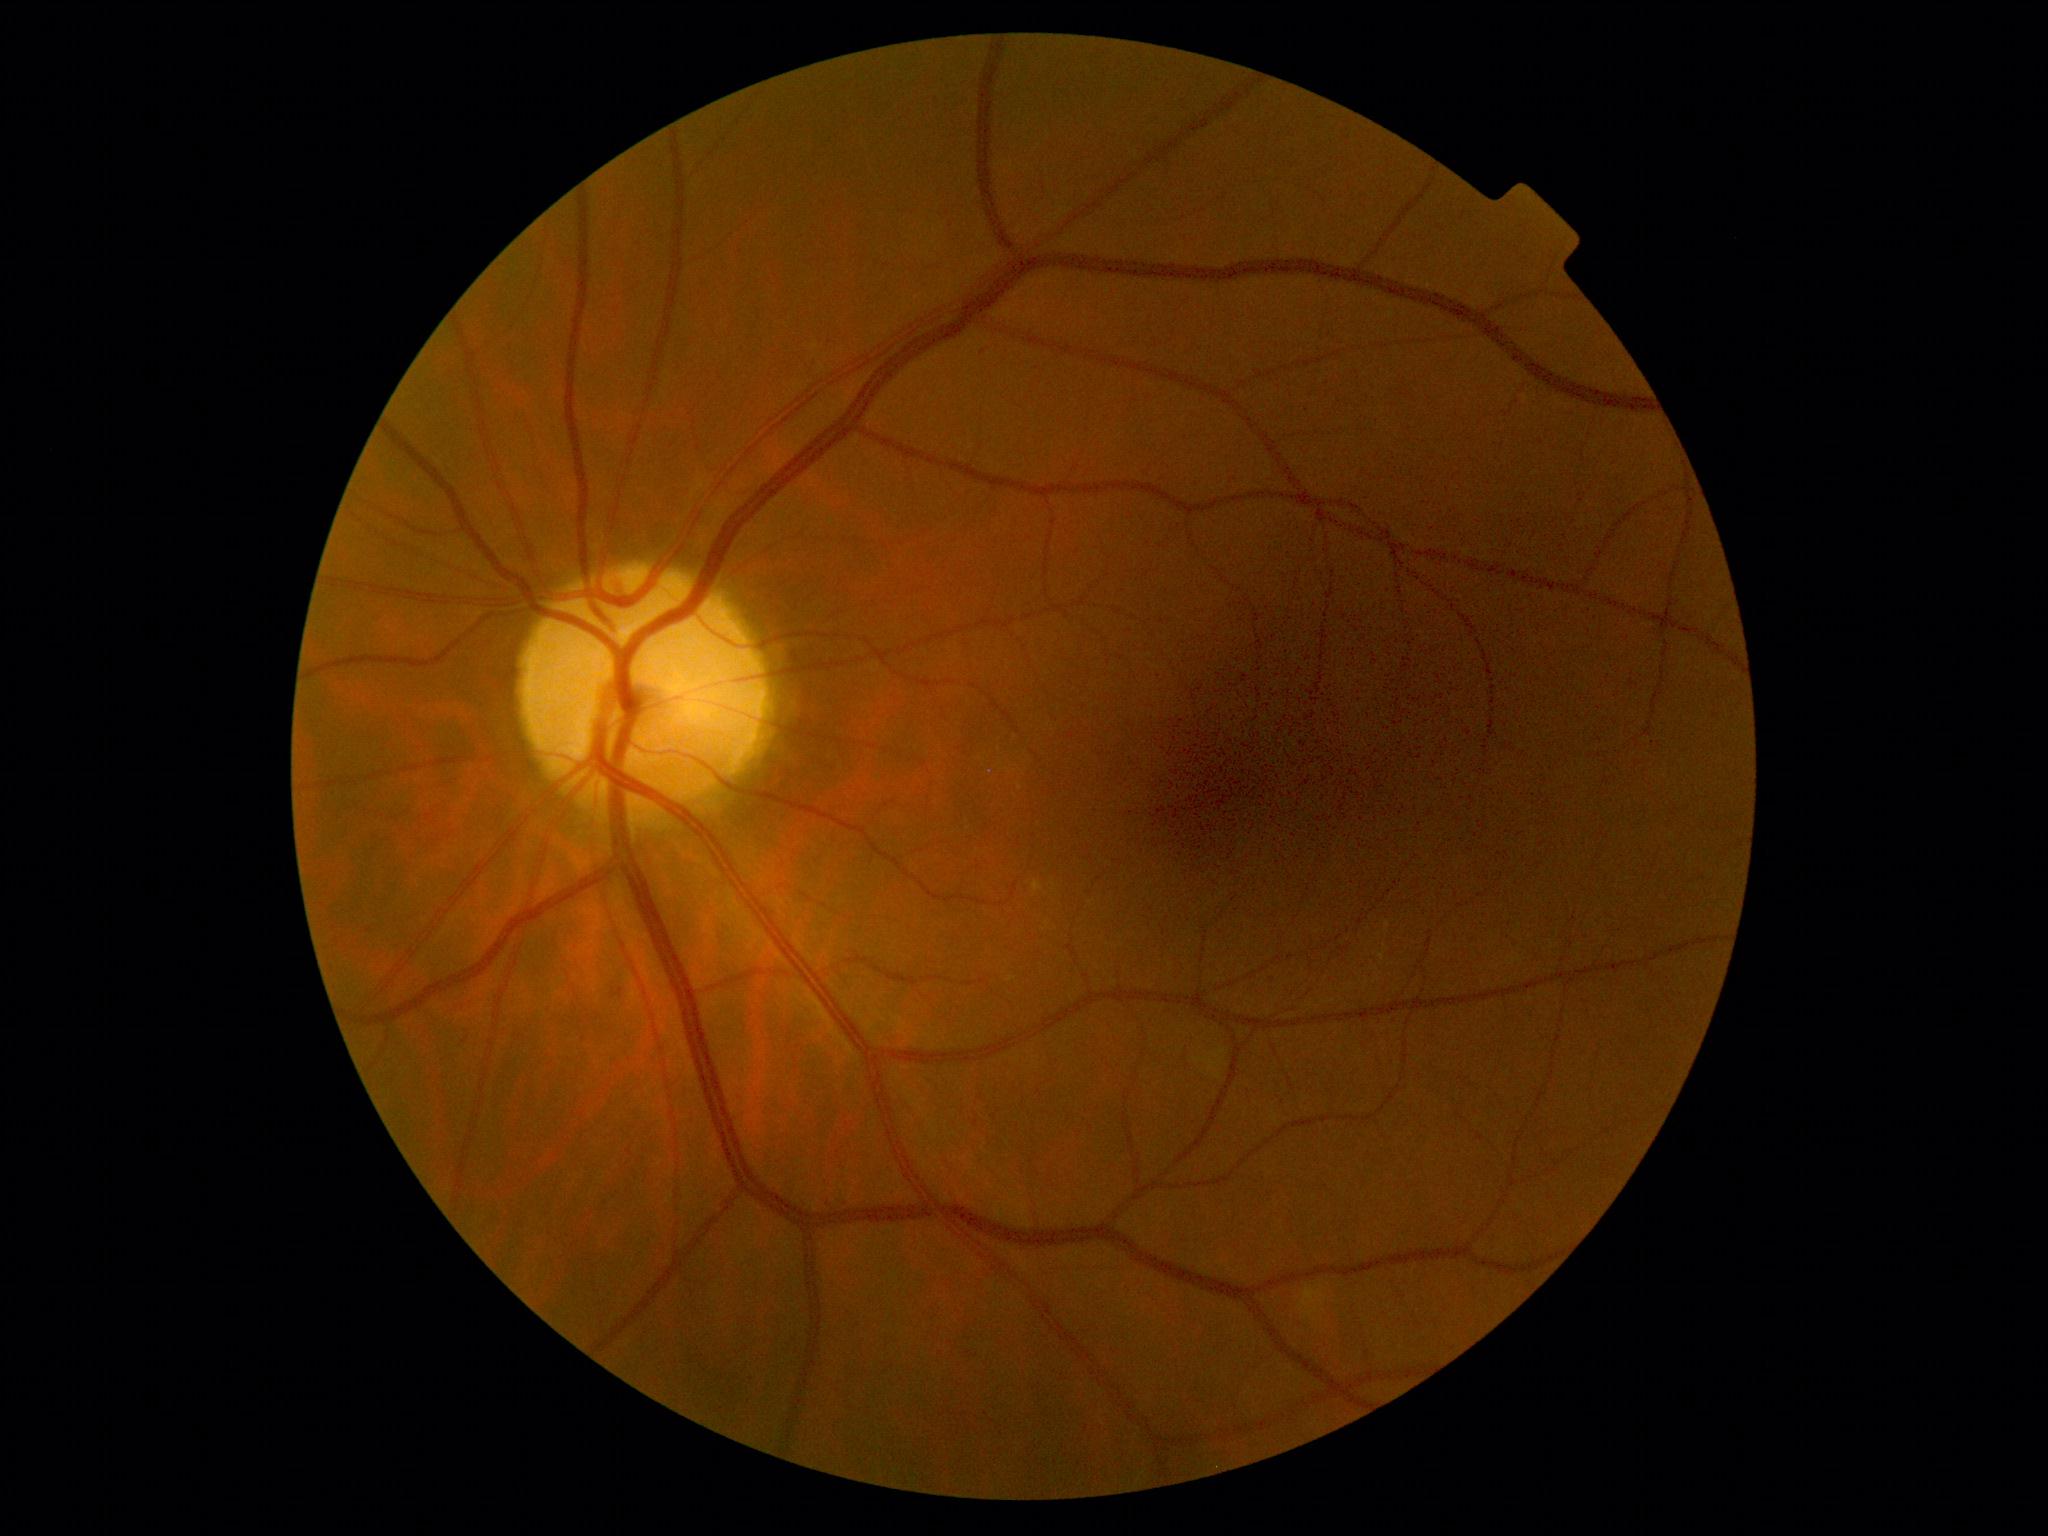
The retinopathy is classified as non-proliferative diabetic retinopathy. DR stage: mild non-proliferative diabetic retinopathy (grade 1).